Retinal fundus photograph.
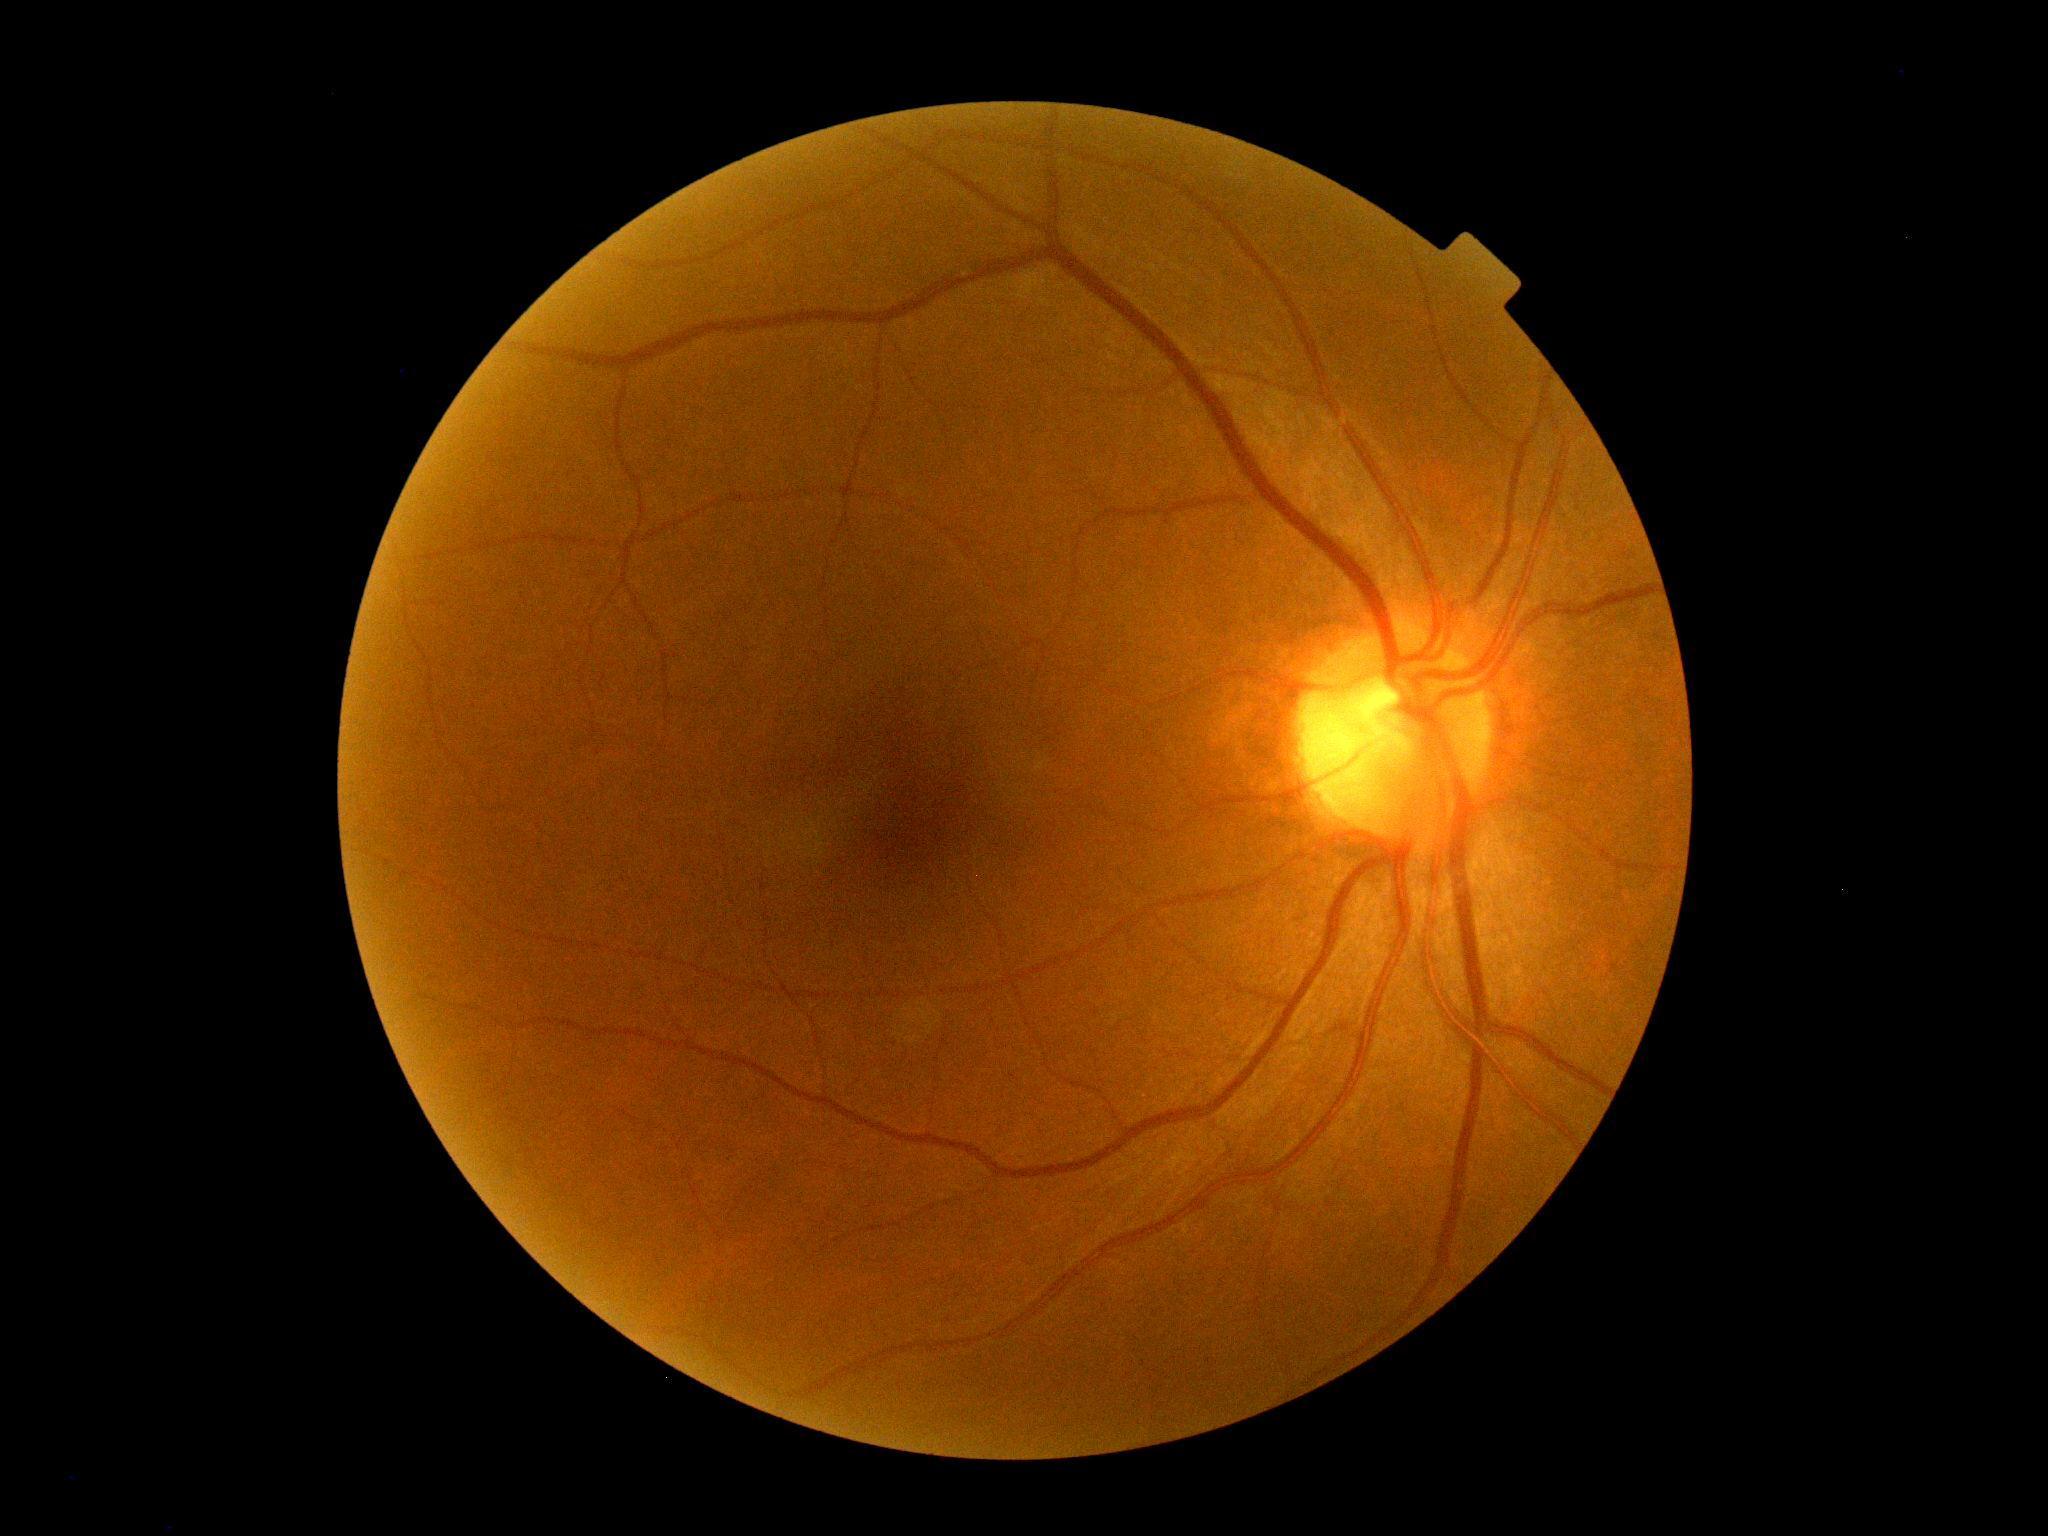 dr_grade: 0
dr_impression: no DR findings